Retinal fundus photograph; 848 x 848 pixels; FOV: 45 degrees; nonmydriatic fundus photograph; NIDEK AFC-230 — 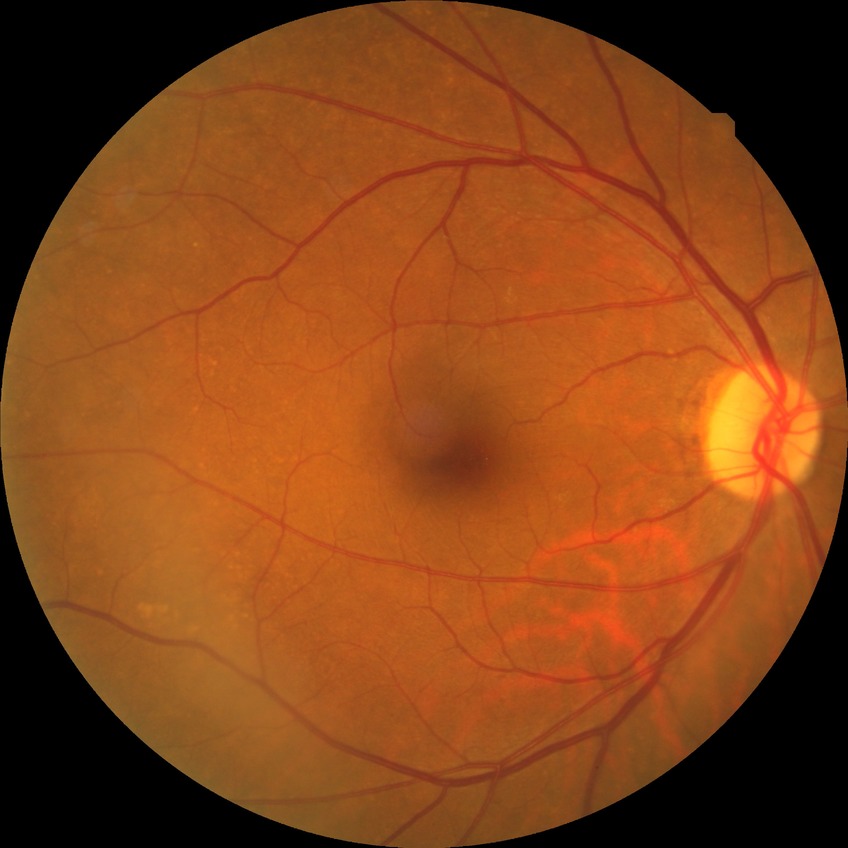
Modified Davis classification: no diabetic retinopathy.